Axial length (AL): 22.83 mm; 65-year-old patient; female
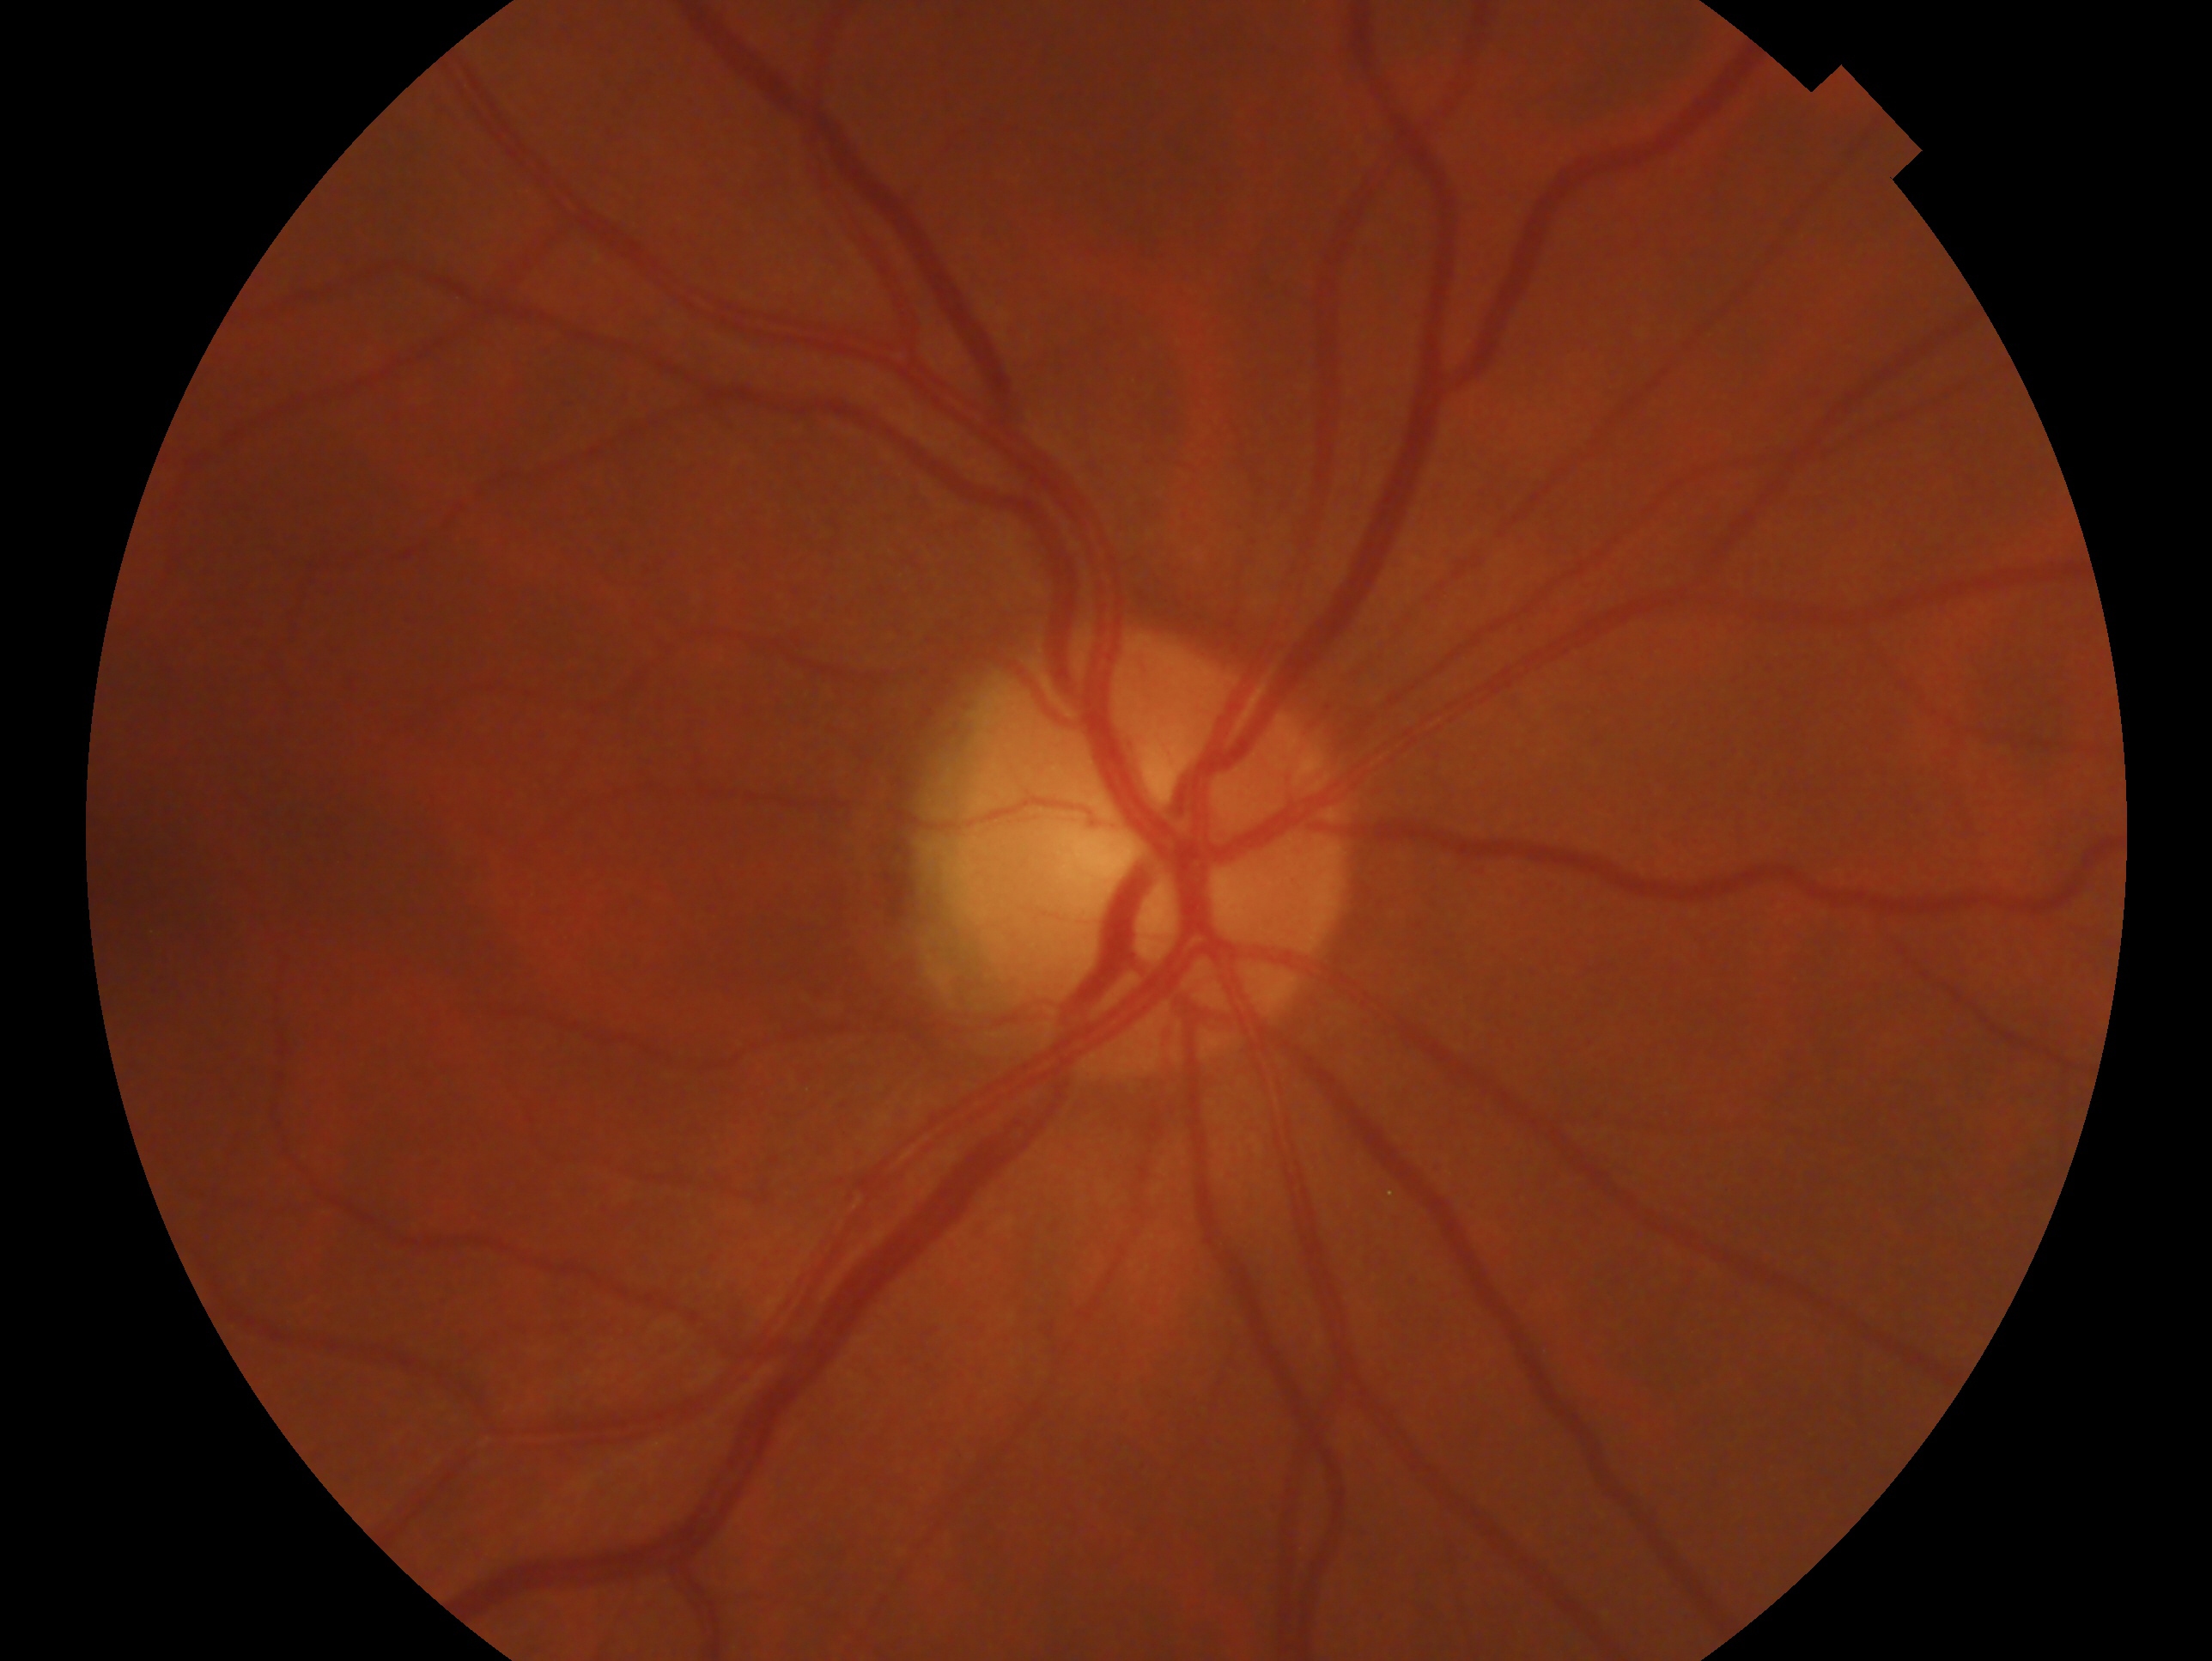 Imaged eye: right. Assessment: no evidence of glaucoma — no clinical evidence of glaucoma in this eye.